FOV: 45 degrees · 2184x1690:
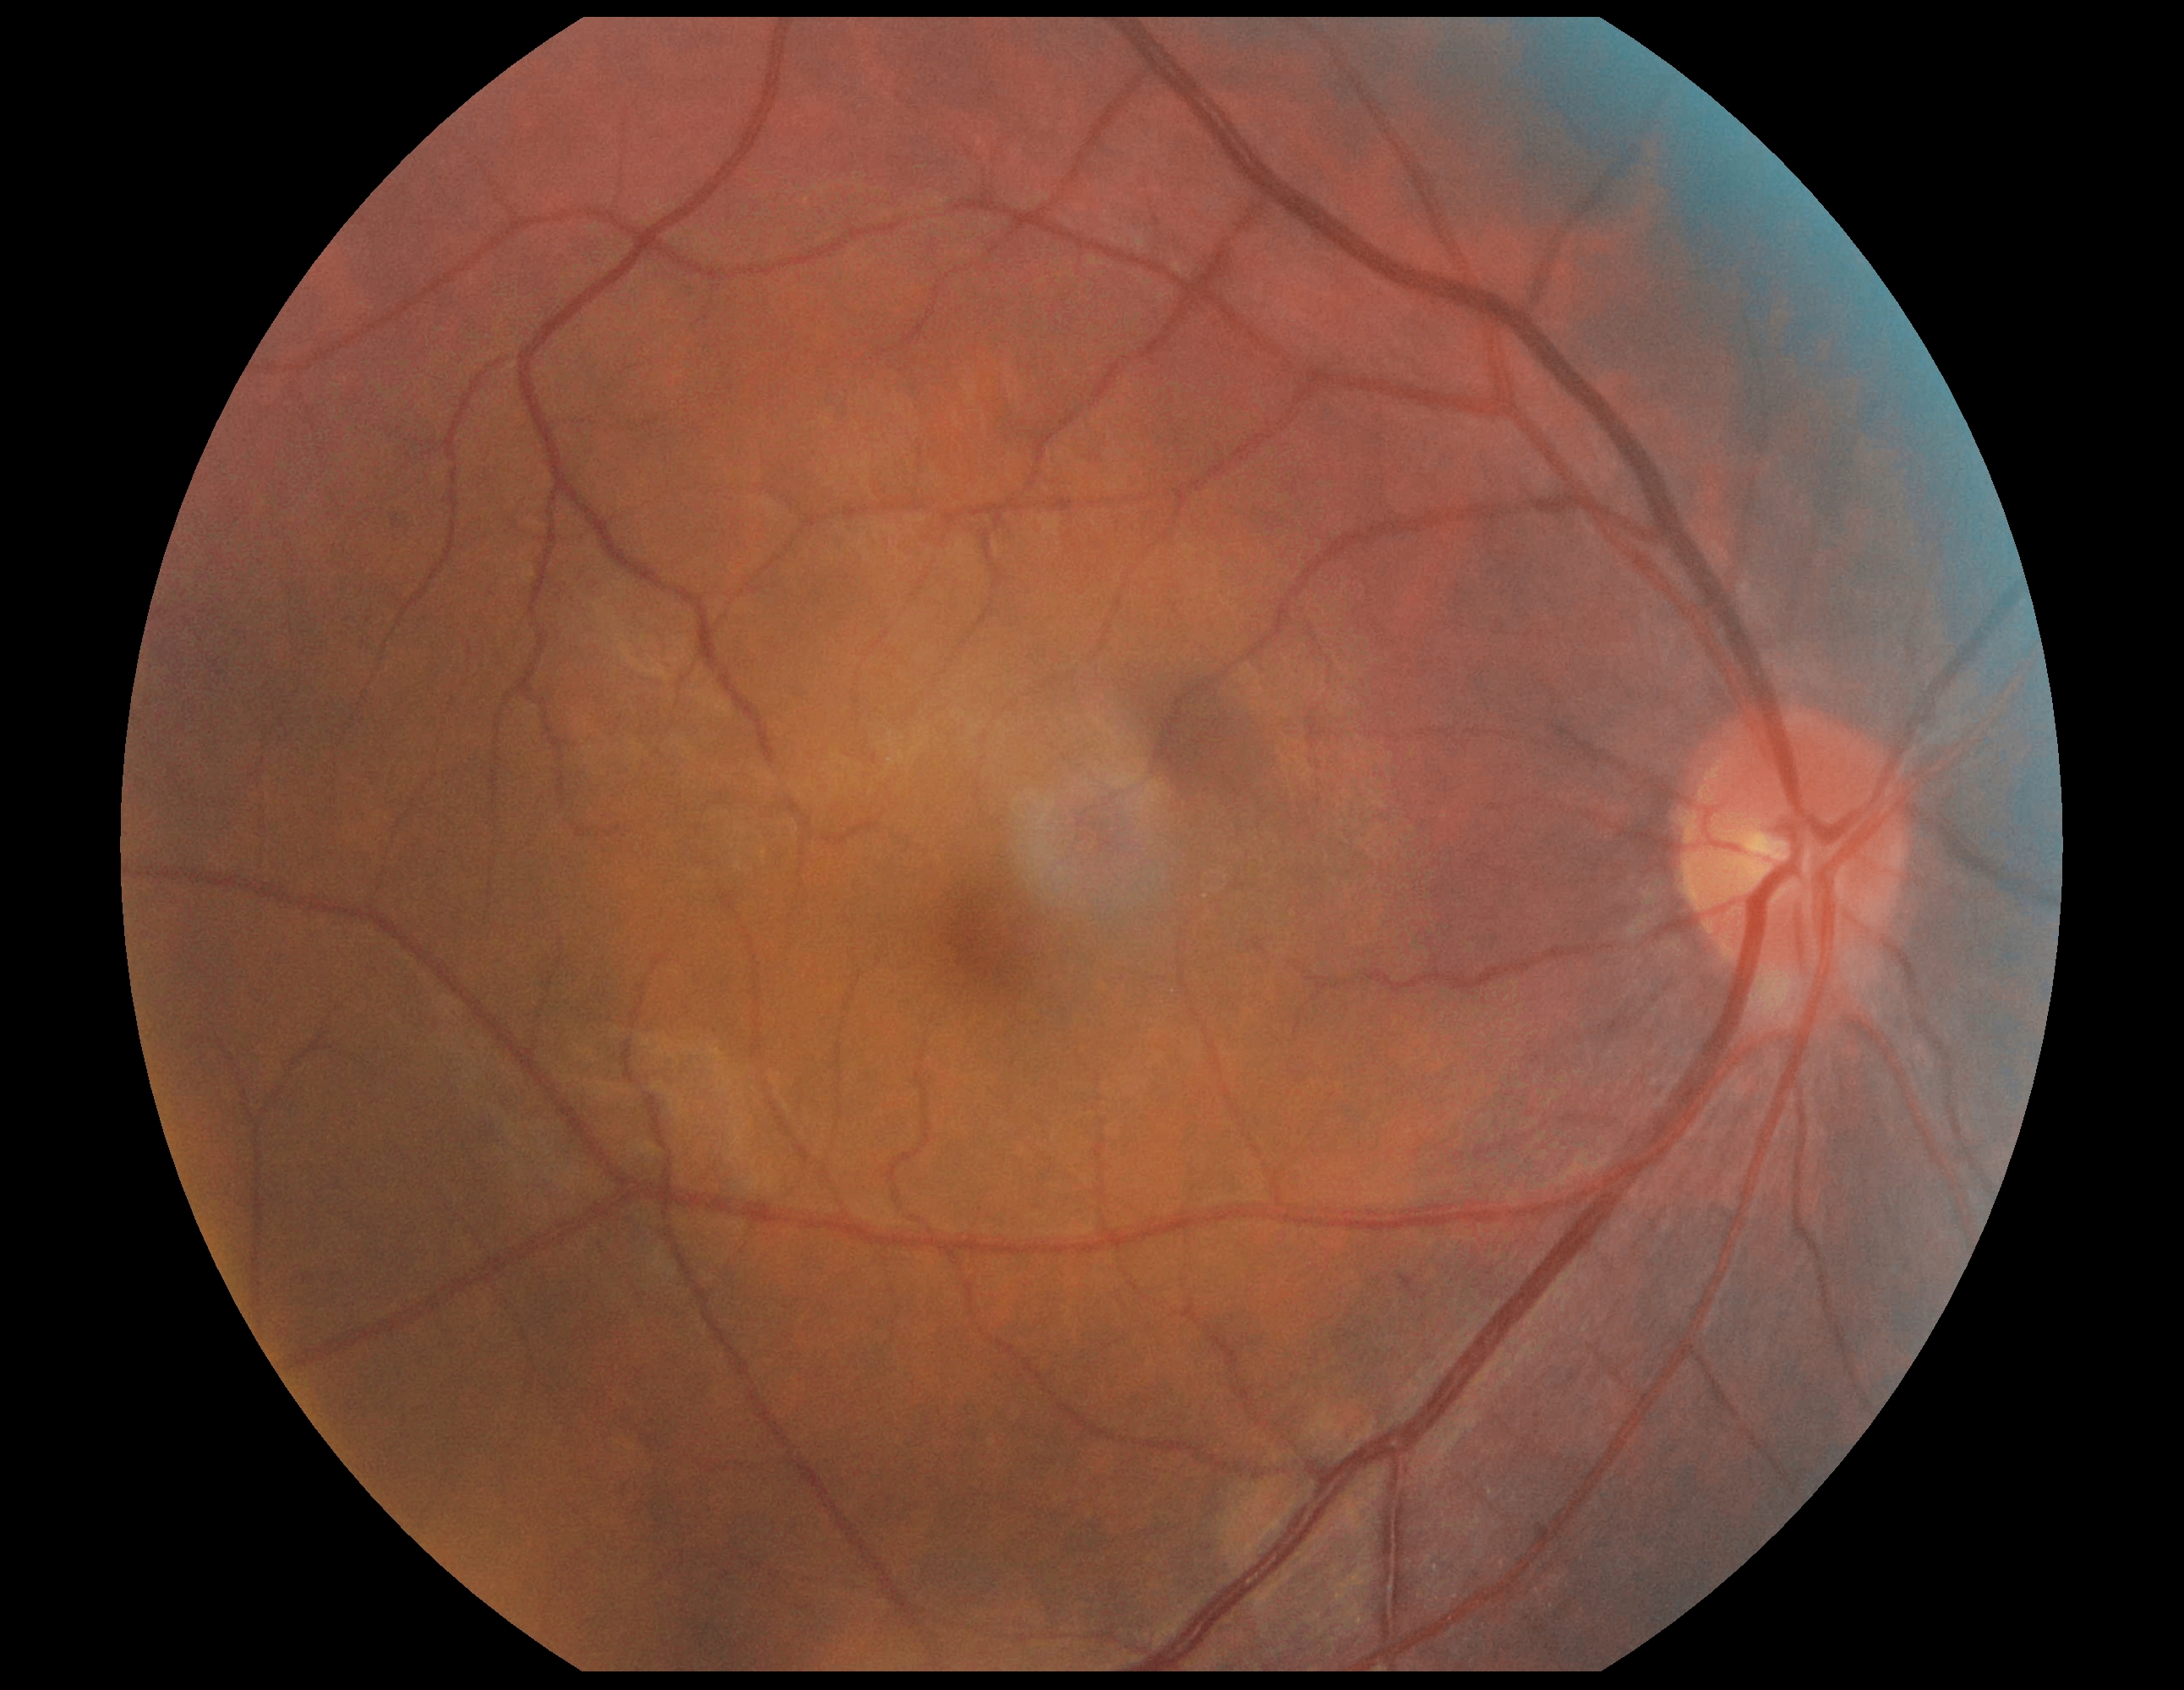 {
  "dr_grade": "0/4"
}